Acquired on the Clarity RetCam 3; RetCam wide-field infant fundus image: 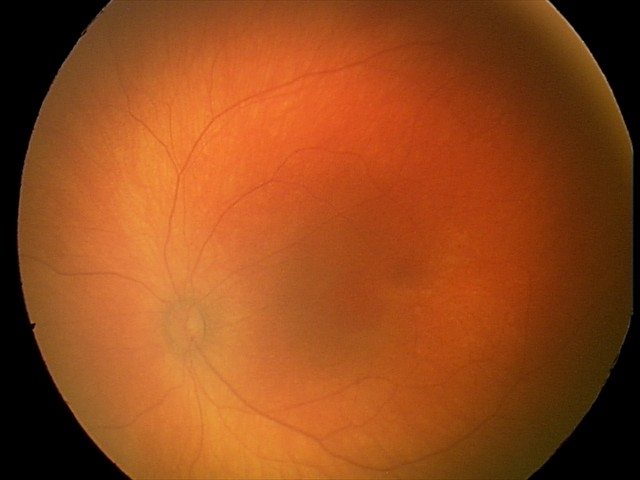

Assessment: physiological retinal finding.